45° FOV · 2352x1568px — 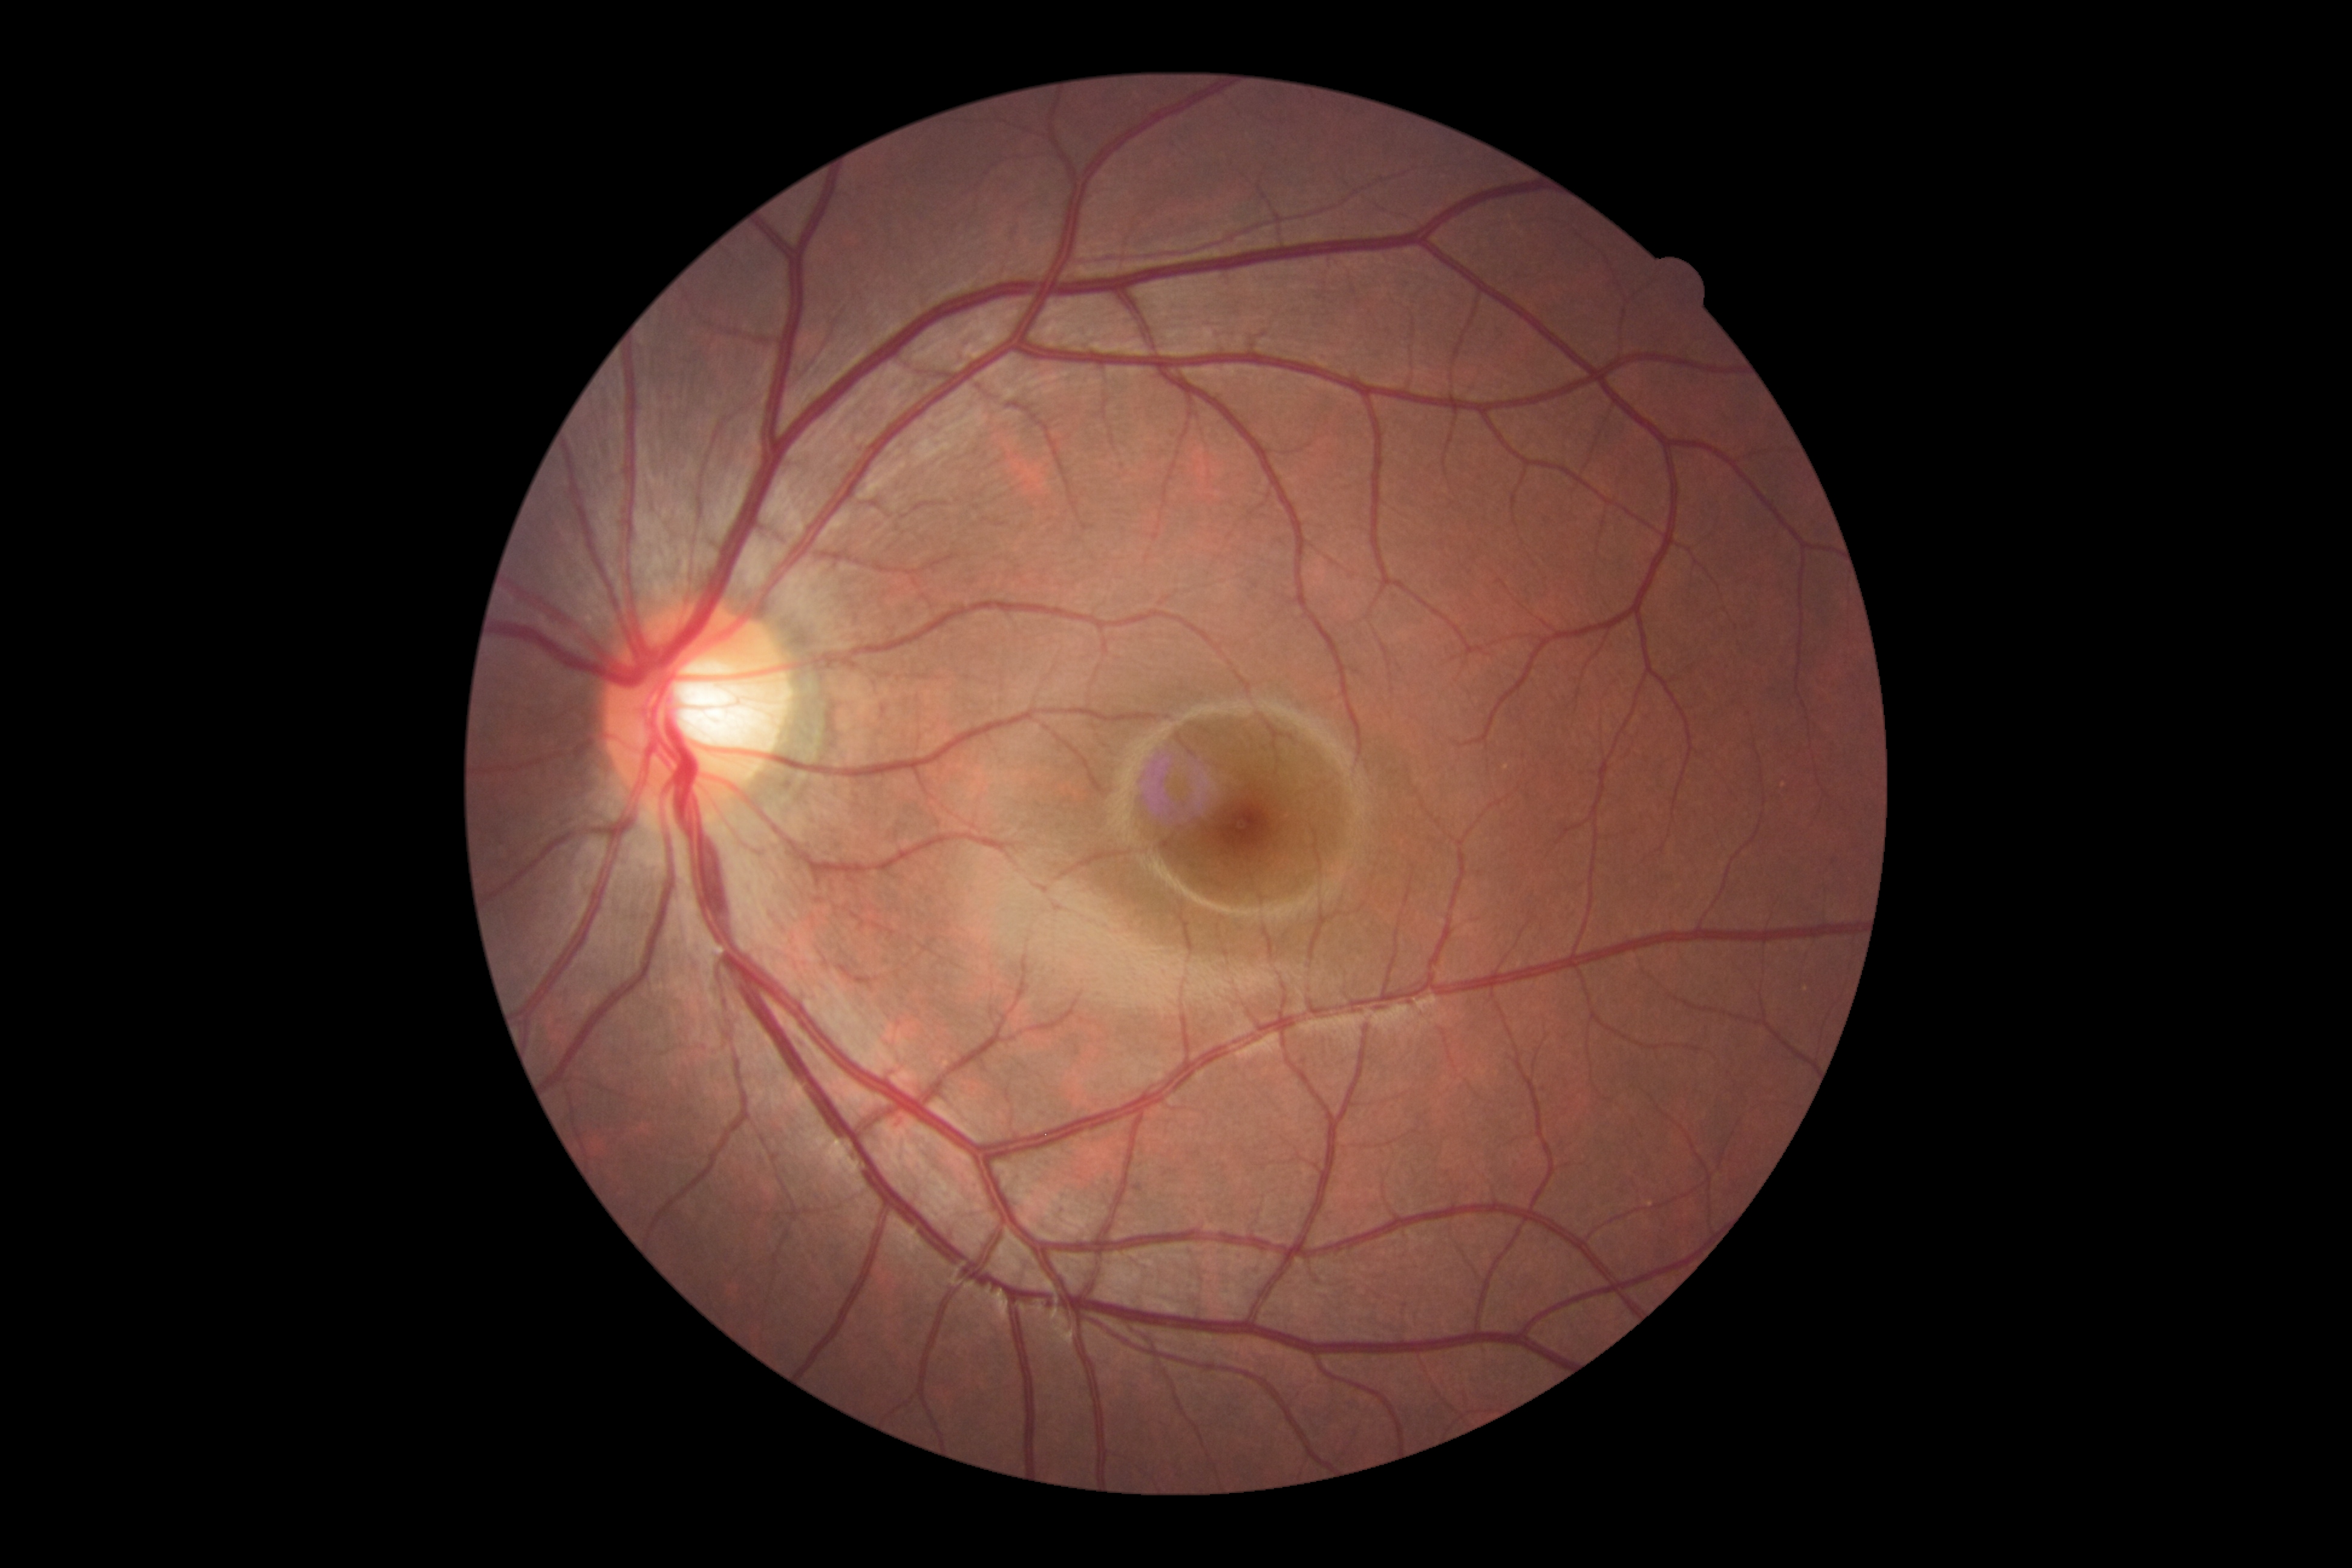
Diabetic retinopathy severity: 0/4.